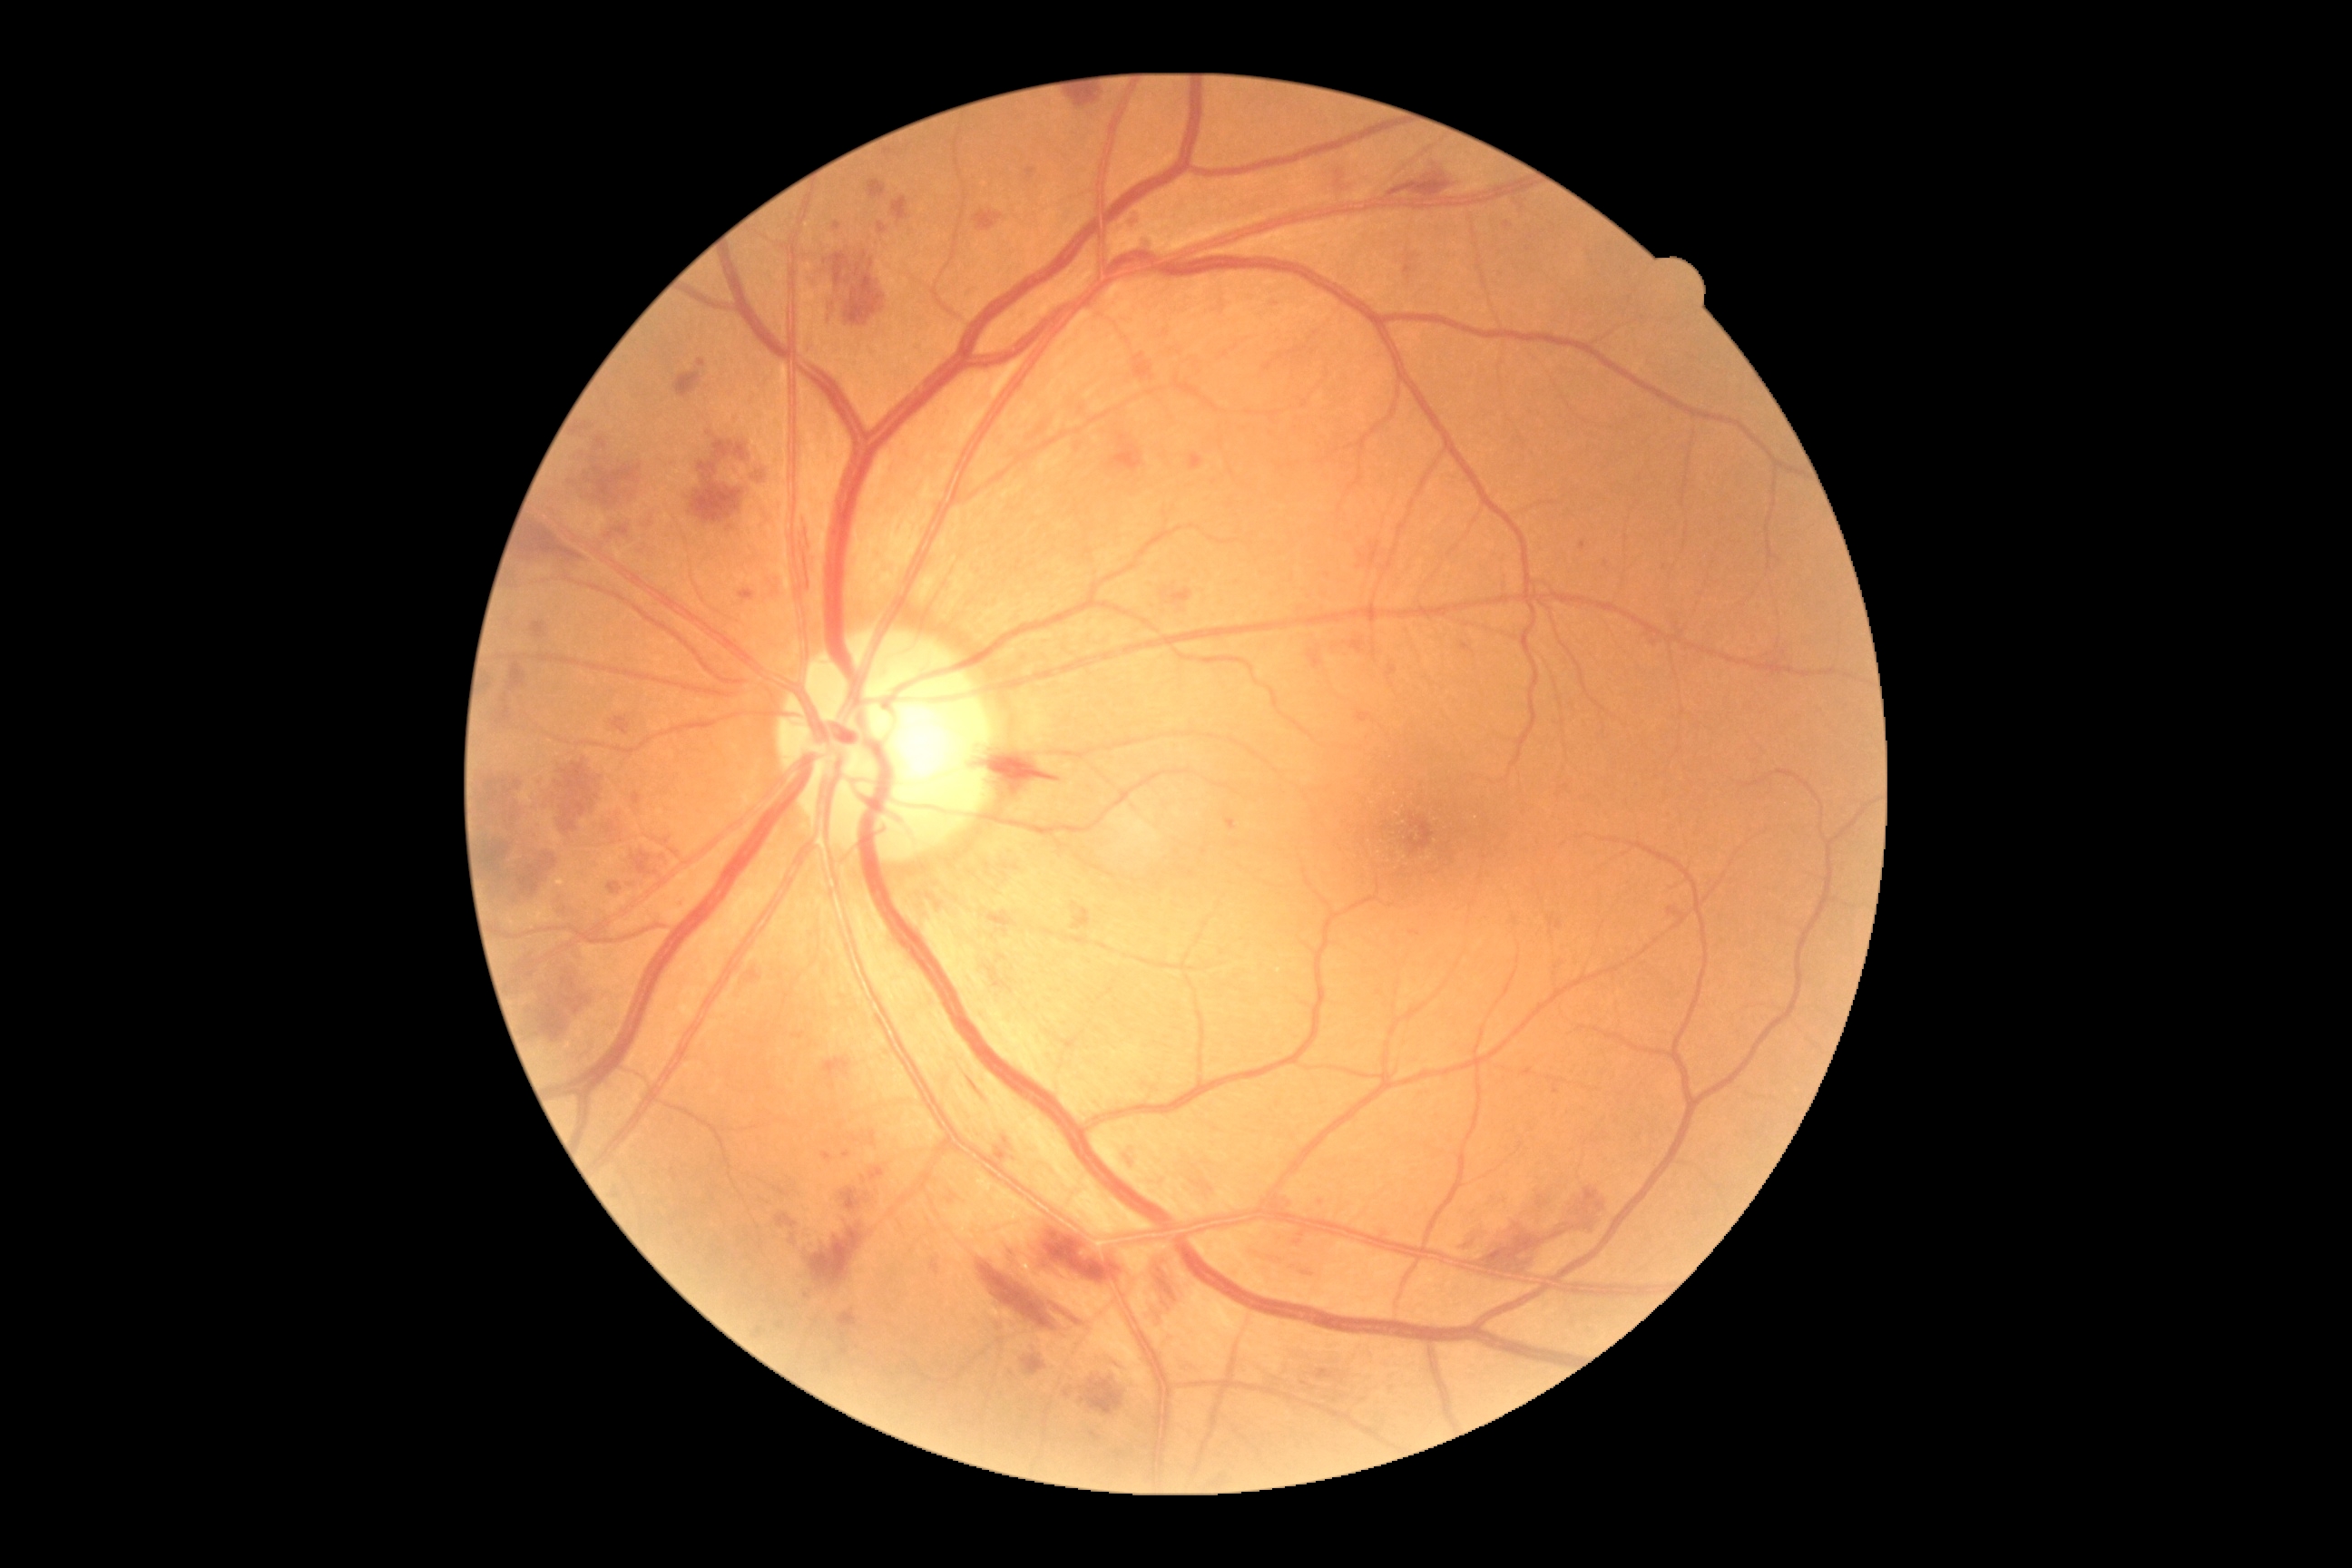 partial: true
dr_grade: 3
dr_grade_name: severe NPDR
lesions:
  ma:
    - box=[1026, 168, 1037, 182]
    - box=[1226, 819, 1237, 832]
    - box=[1126, 210, 1141, 231]
    - box=[1505, 222, 1511, 230]
    - box=[756, 1328, 763, 1337]
    - box=[1092, 1433, 1101, 1442]
    - box=[1317, 1369, 1333, 1380]
    - box=[1556, 921, 1563, 930]
    - box=[1012, 1253, 1021, 1264]
    - box=[885, 150, 894, 155]
    - box=[1371, 645, 1377, 660]
    - box=[1335, 172, 1346, 191]
    - box=[852, 1137, 861, 1144]
    - box=[868, 1132, 876, 1148]
    - box=[1302, 1271, 1313, 1277]
  ma_small:
    - [x=950, y=1201]
    - [x=780, y=1326]
    - [x=1665, y=569]
    - [x=1067, y=1394]
  he:
    - box=[1081, 1380, 1124, 1416]
    - box=[805, 518, 814, 551]
    - box=[1242, 1250, 1284, 1264]
    - box=[838, 1311, 858, 1328]
    - box=[692, 464, 743, 524]
    - box=[770, 574, 785, 605]
    - box=[1124, 1146, 1139, 1171]
    - box=[1130, 211, 1142, 231]
    - box=[1380, 172, 1456, 202]
    - box=[1351, 642, 1364, 654]
    - box=[972, 752, 1070, 796]
    - box=[823, 1059, 850, 1090]
    - box=[674, 373, 701, 398]
    - box=[1133, 353, 1155, 380]
    - box=[1028, 1224, 1124, 1282]
    - box=[1326, 643, 1349, 662]